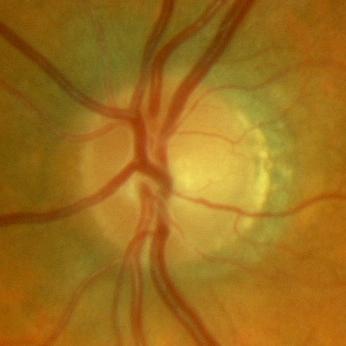

Optic nerve head photograph demonstrating no glaucomatous changes.